Ultra-widefield fundus mosaic
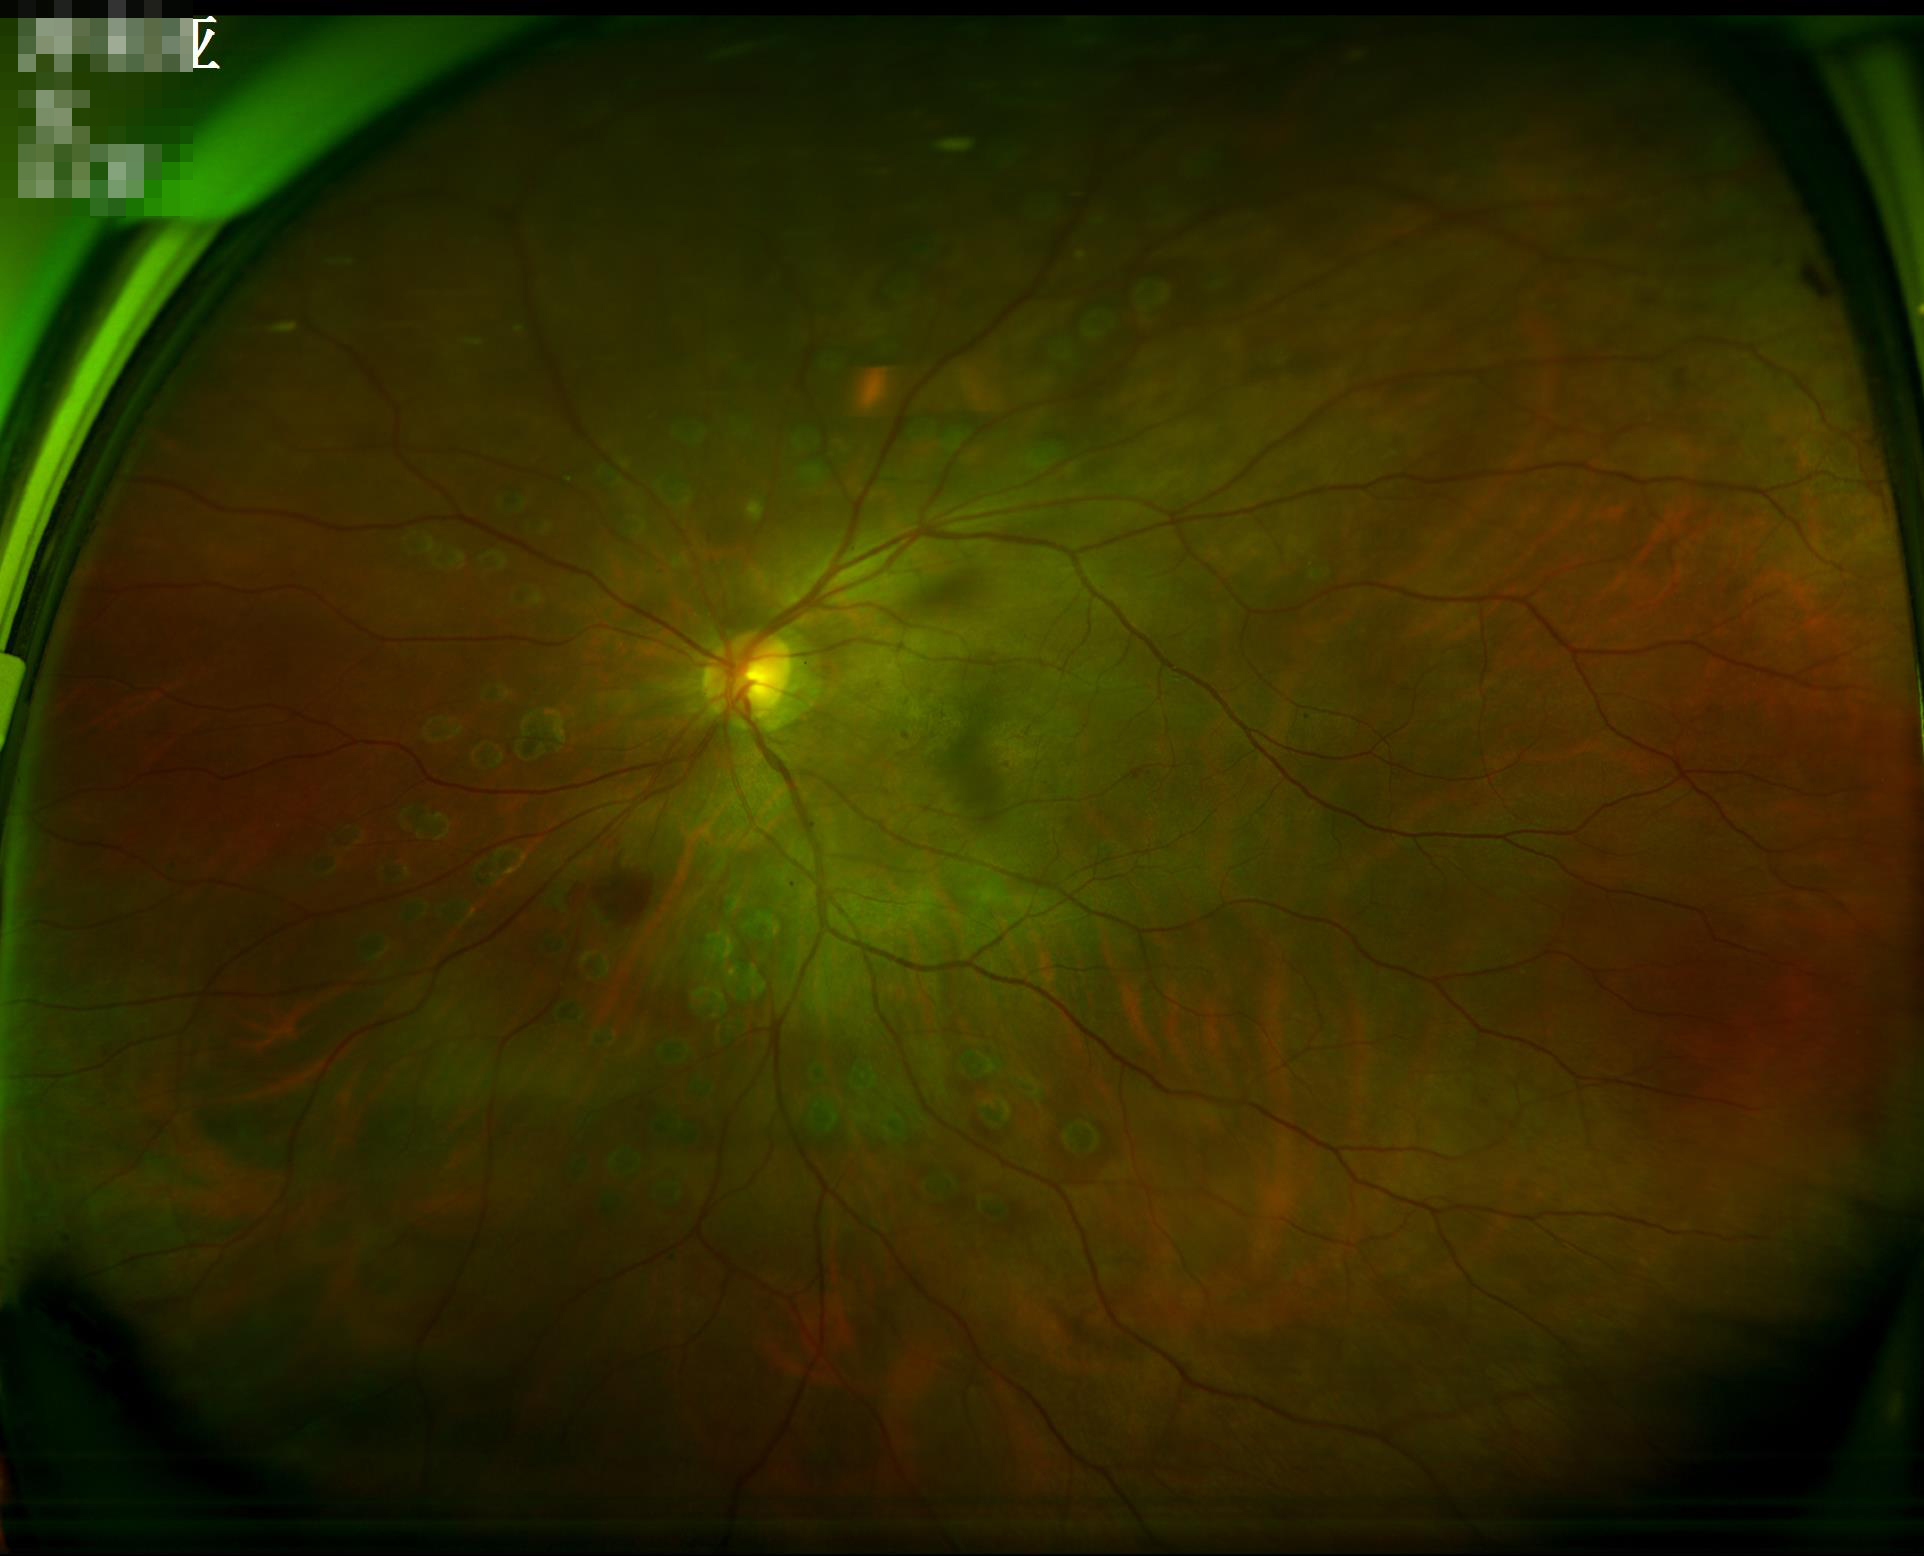
Overall quality: good and suitable for diagnostic use | Focus: clear with no noticeable blur | Contrast: good dynamic range.